FOV: 45 degrees
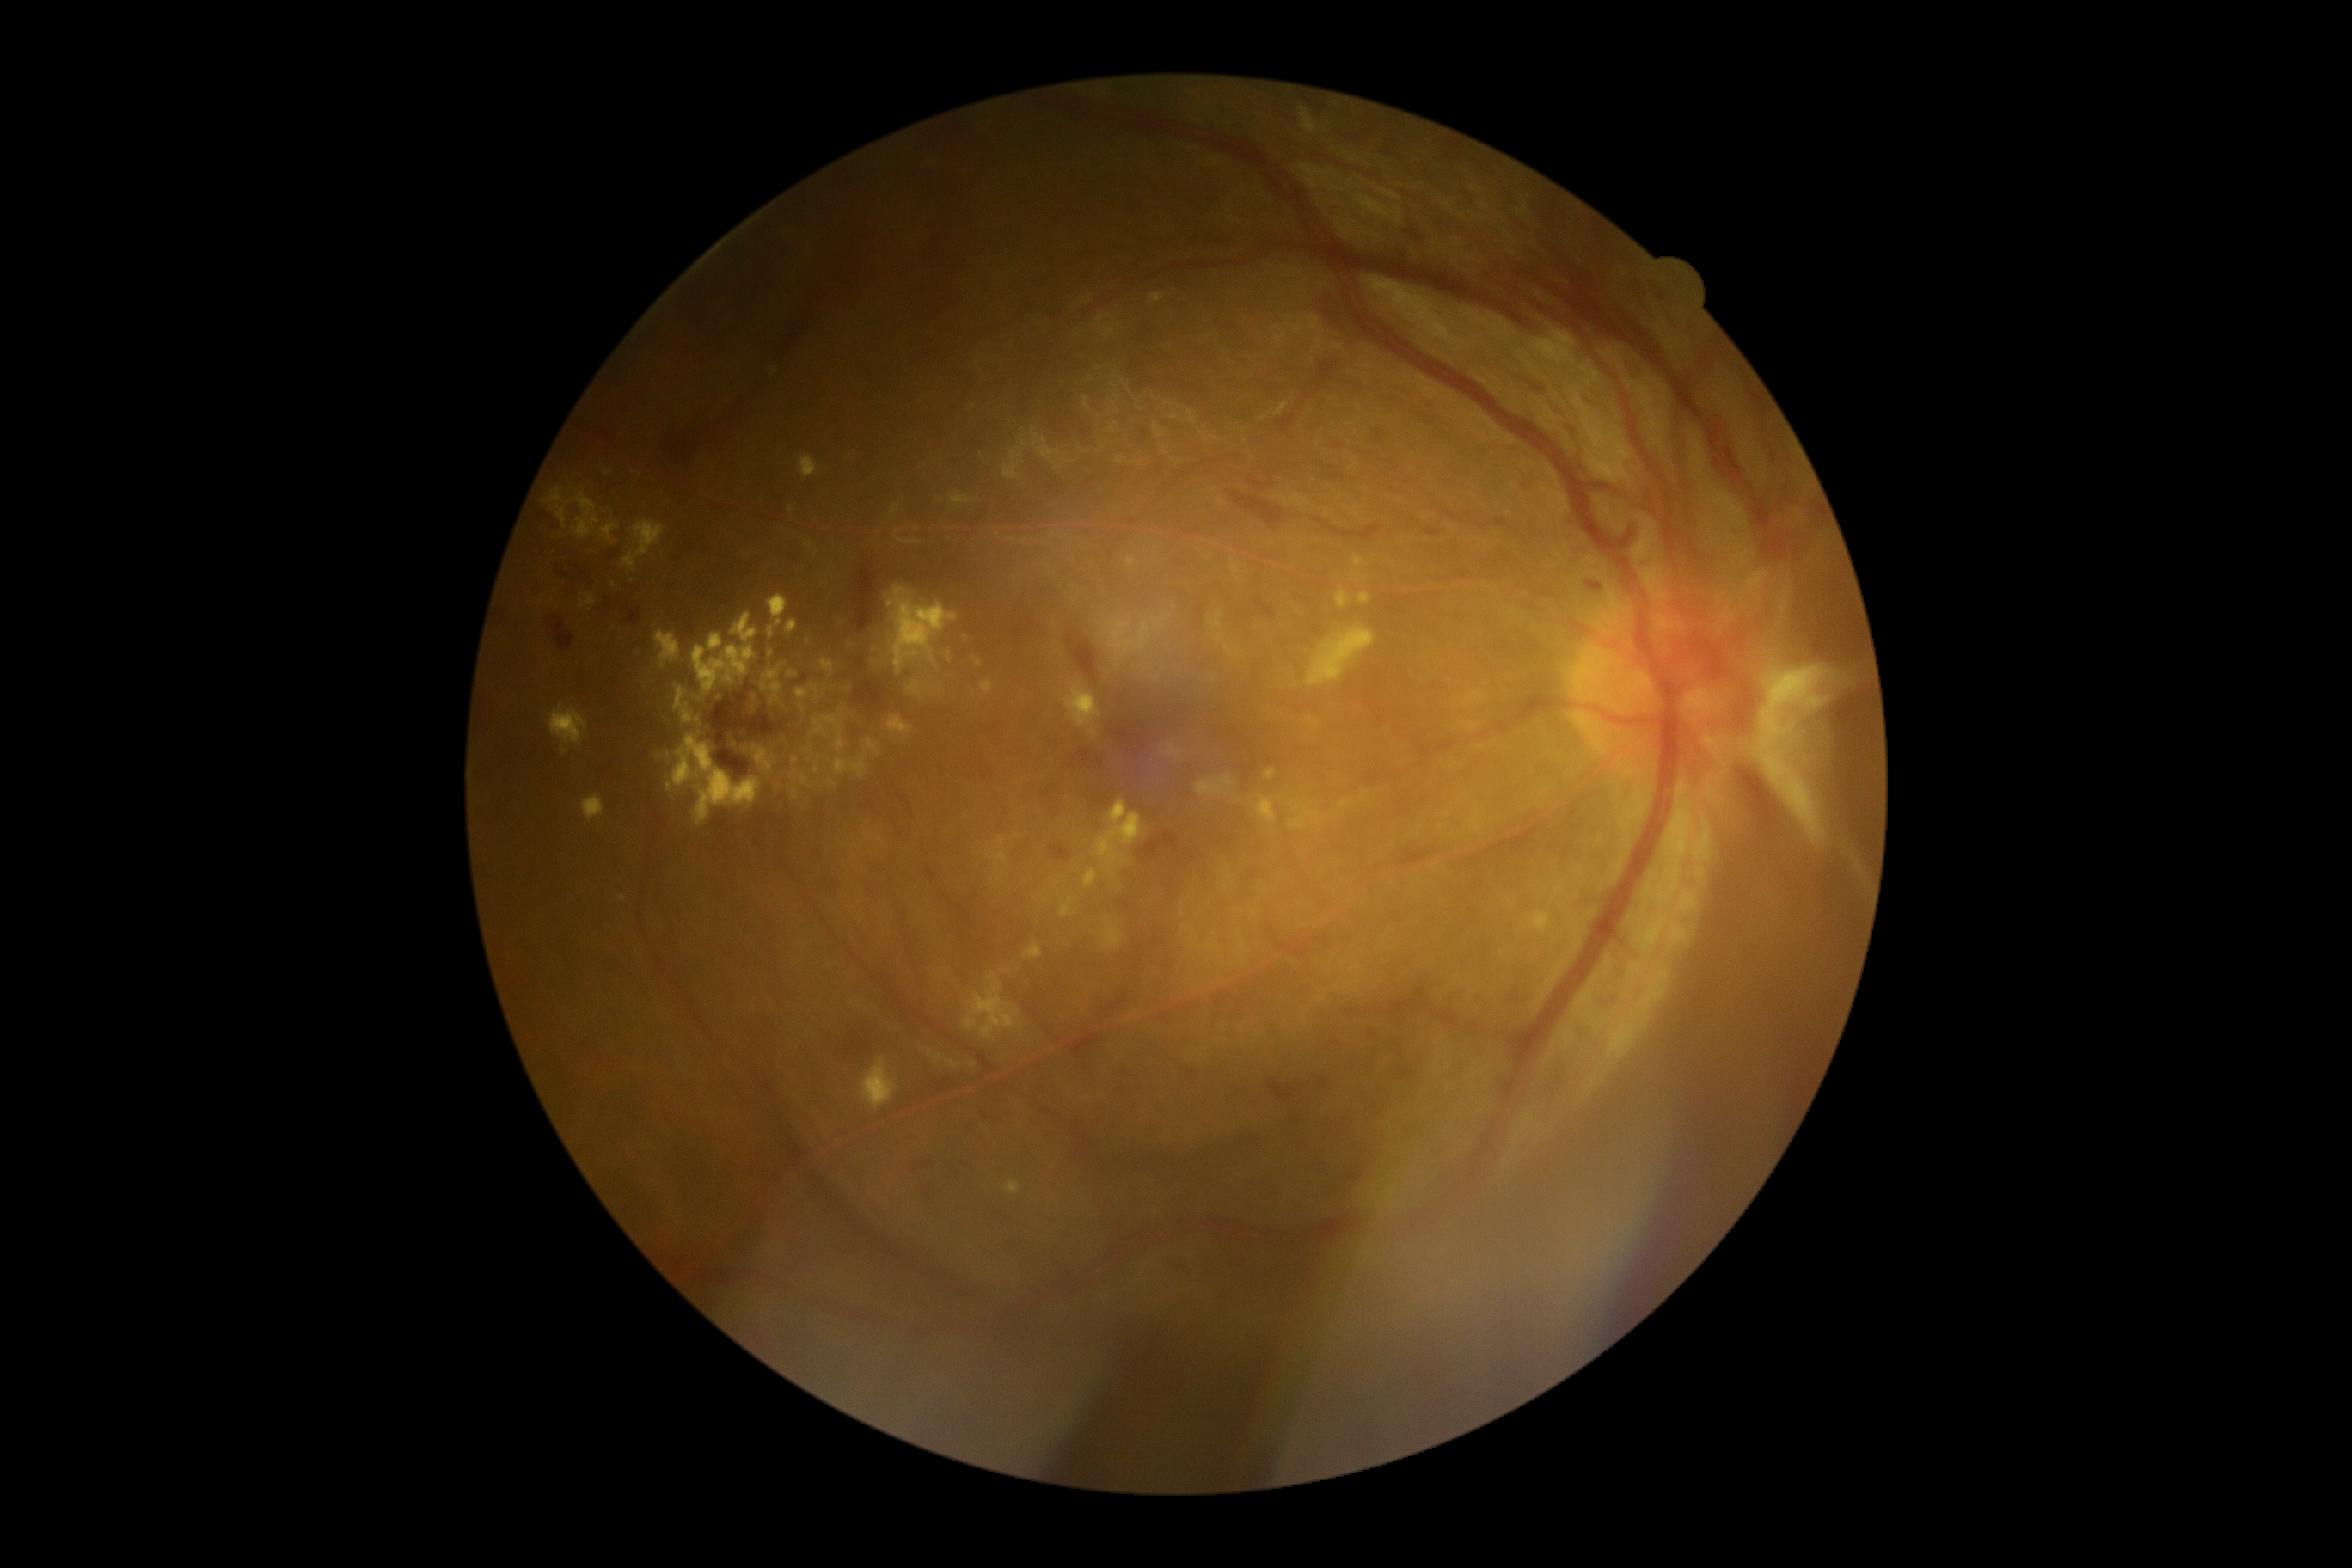

{"partial": true, "dr_grade": 4, "dr_grade_name": "PDR", "lesions": {"ex": [[675, 687, 694, 725], [747, 692, 761, 716], [988, 838, 1008, 869], [792, 769, 809, 787], [964, 972, 1020, 1039], [866, 738, 879, 756], [1230, 563, 1242, 575], [812, 716, 840, 735], [814, 763, 819, 775], [1149, 293, 1168, 305], [716, 692, 725, 702], [1354, 558, 1366, 568], [572, 494, 601, 539]], "ex_small_approx": [[843, 624], [790, 509], [1182, 913], [974, 1066]]}}